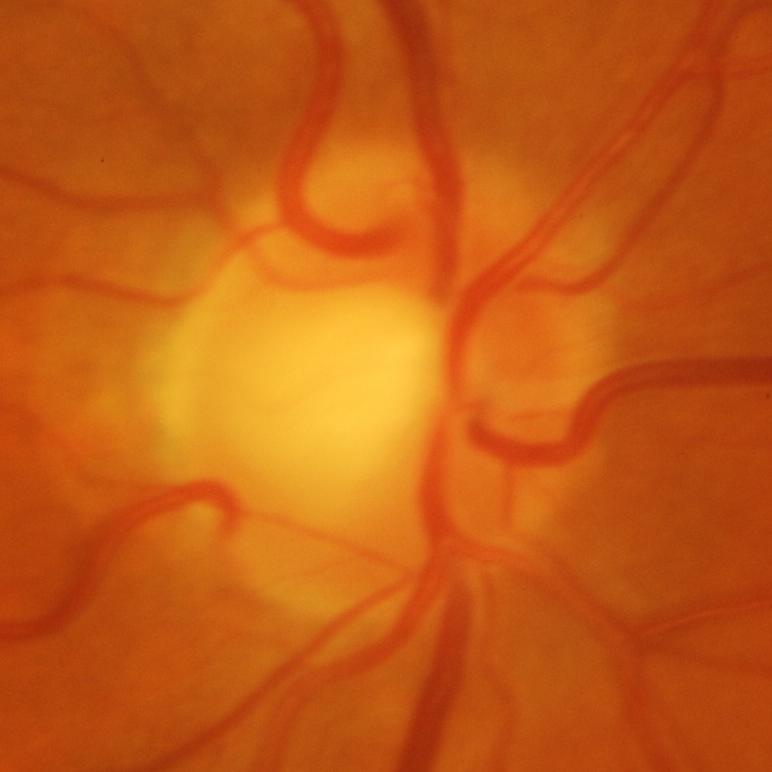
Glaucomatous optic neuropathy is present.
Evidence of glaucoma.